1470x1137, fundus photo, 45° FOV
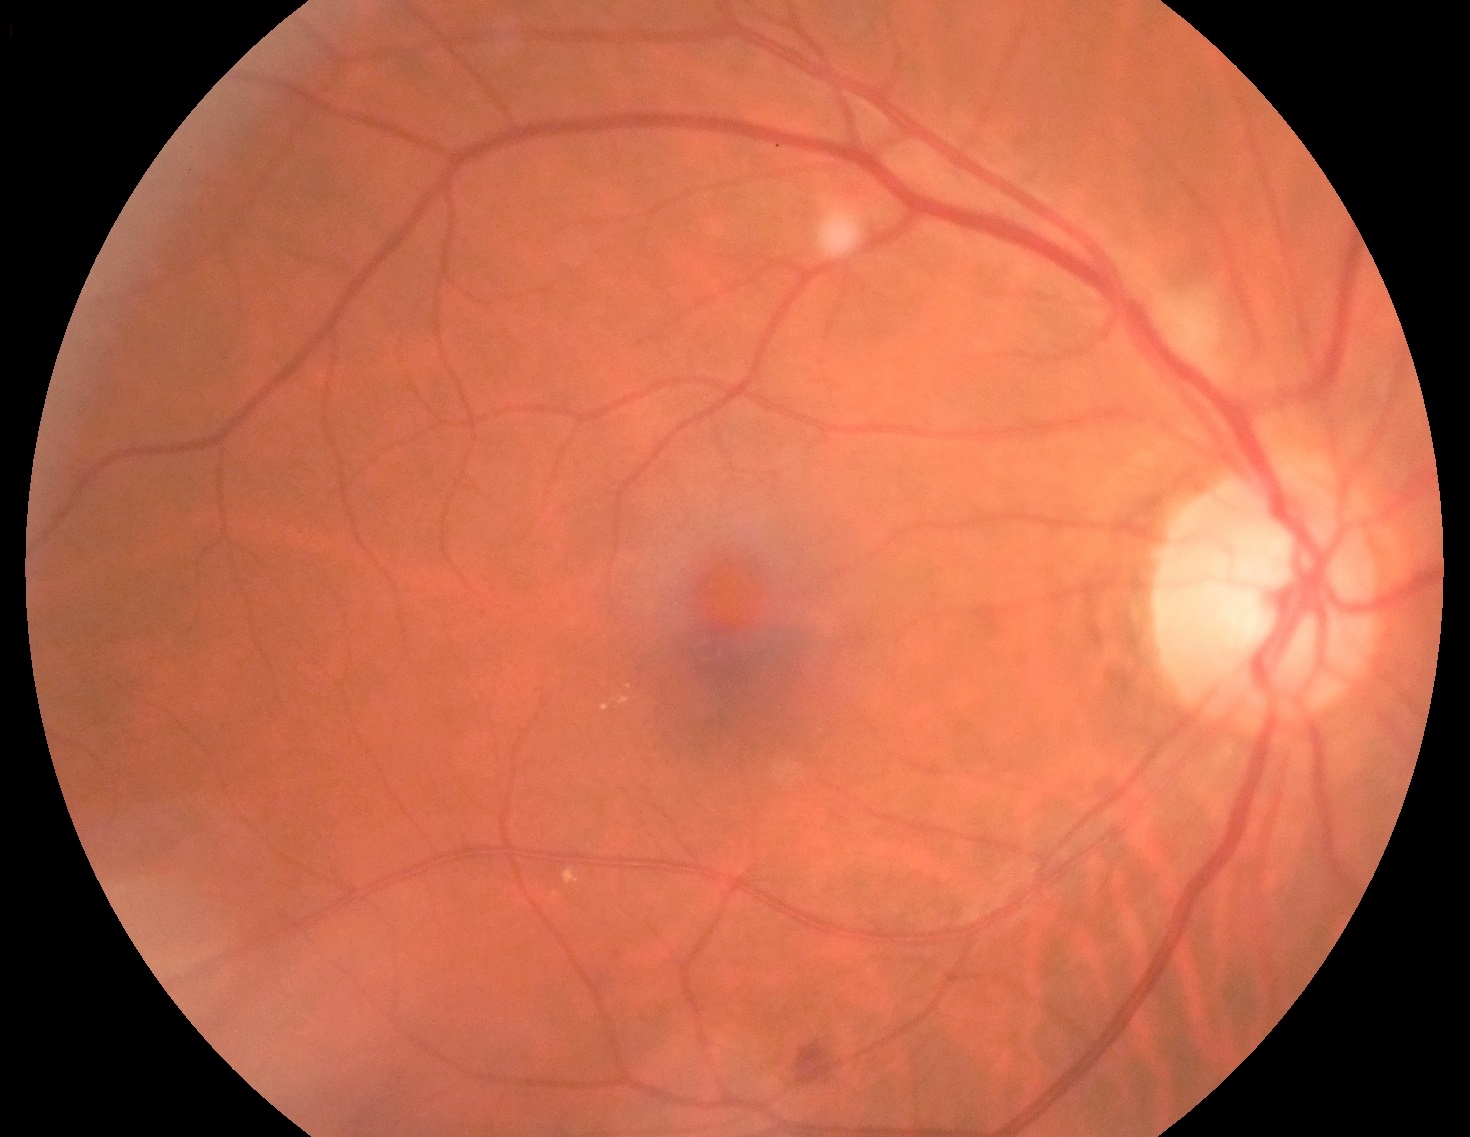
{"dr_category": "non-proliferative diabetic retinopathy", "dr_grade": "grade 2 (moderate NPDR)"}